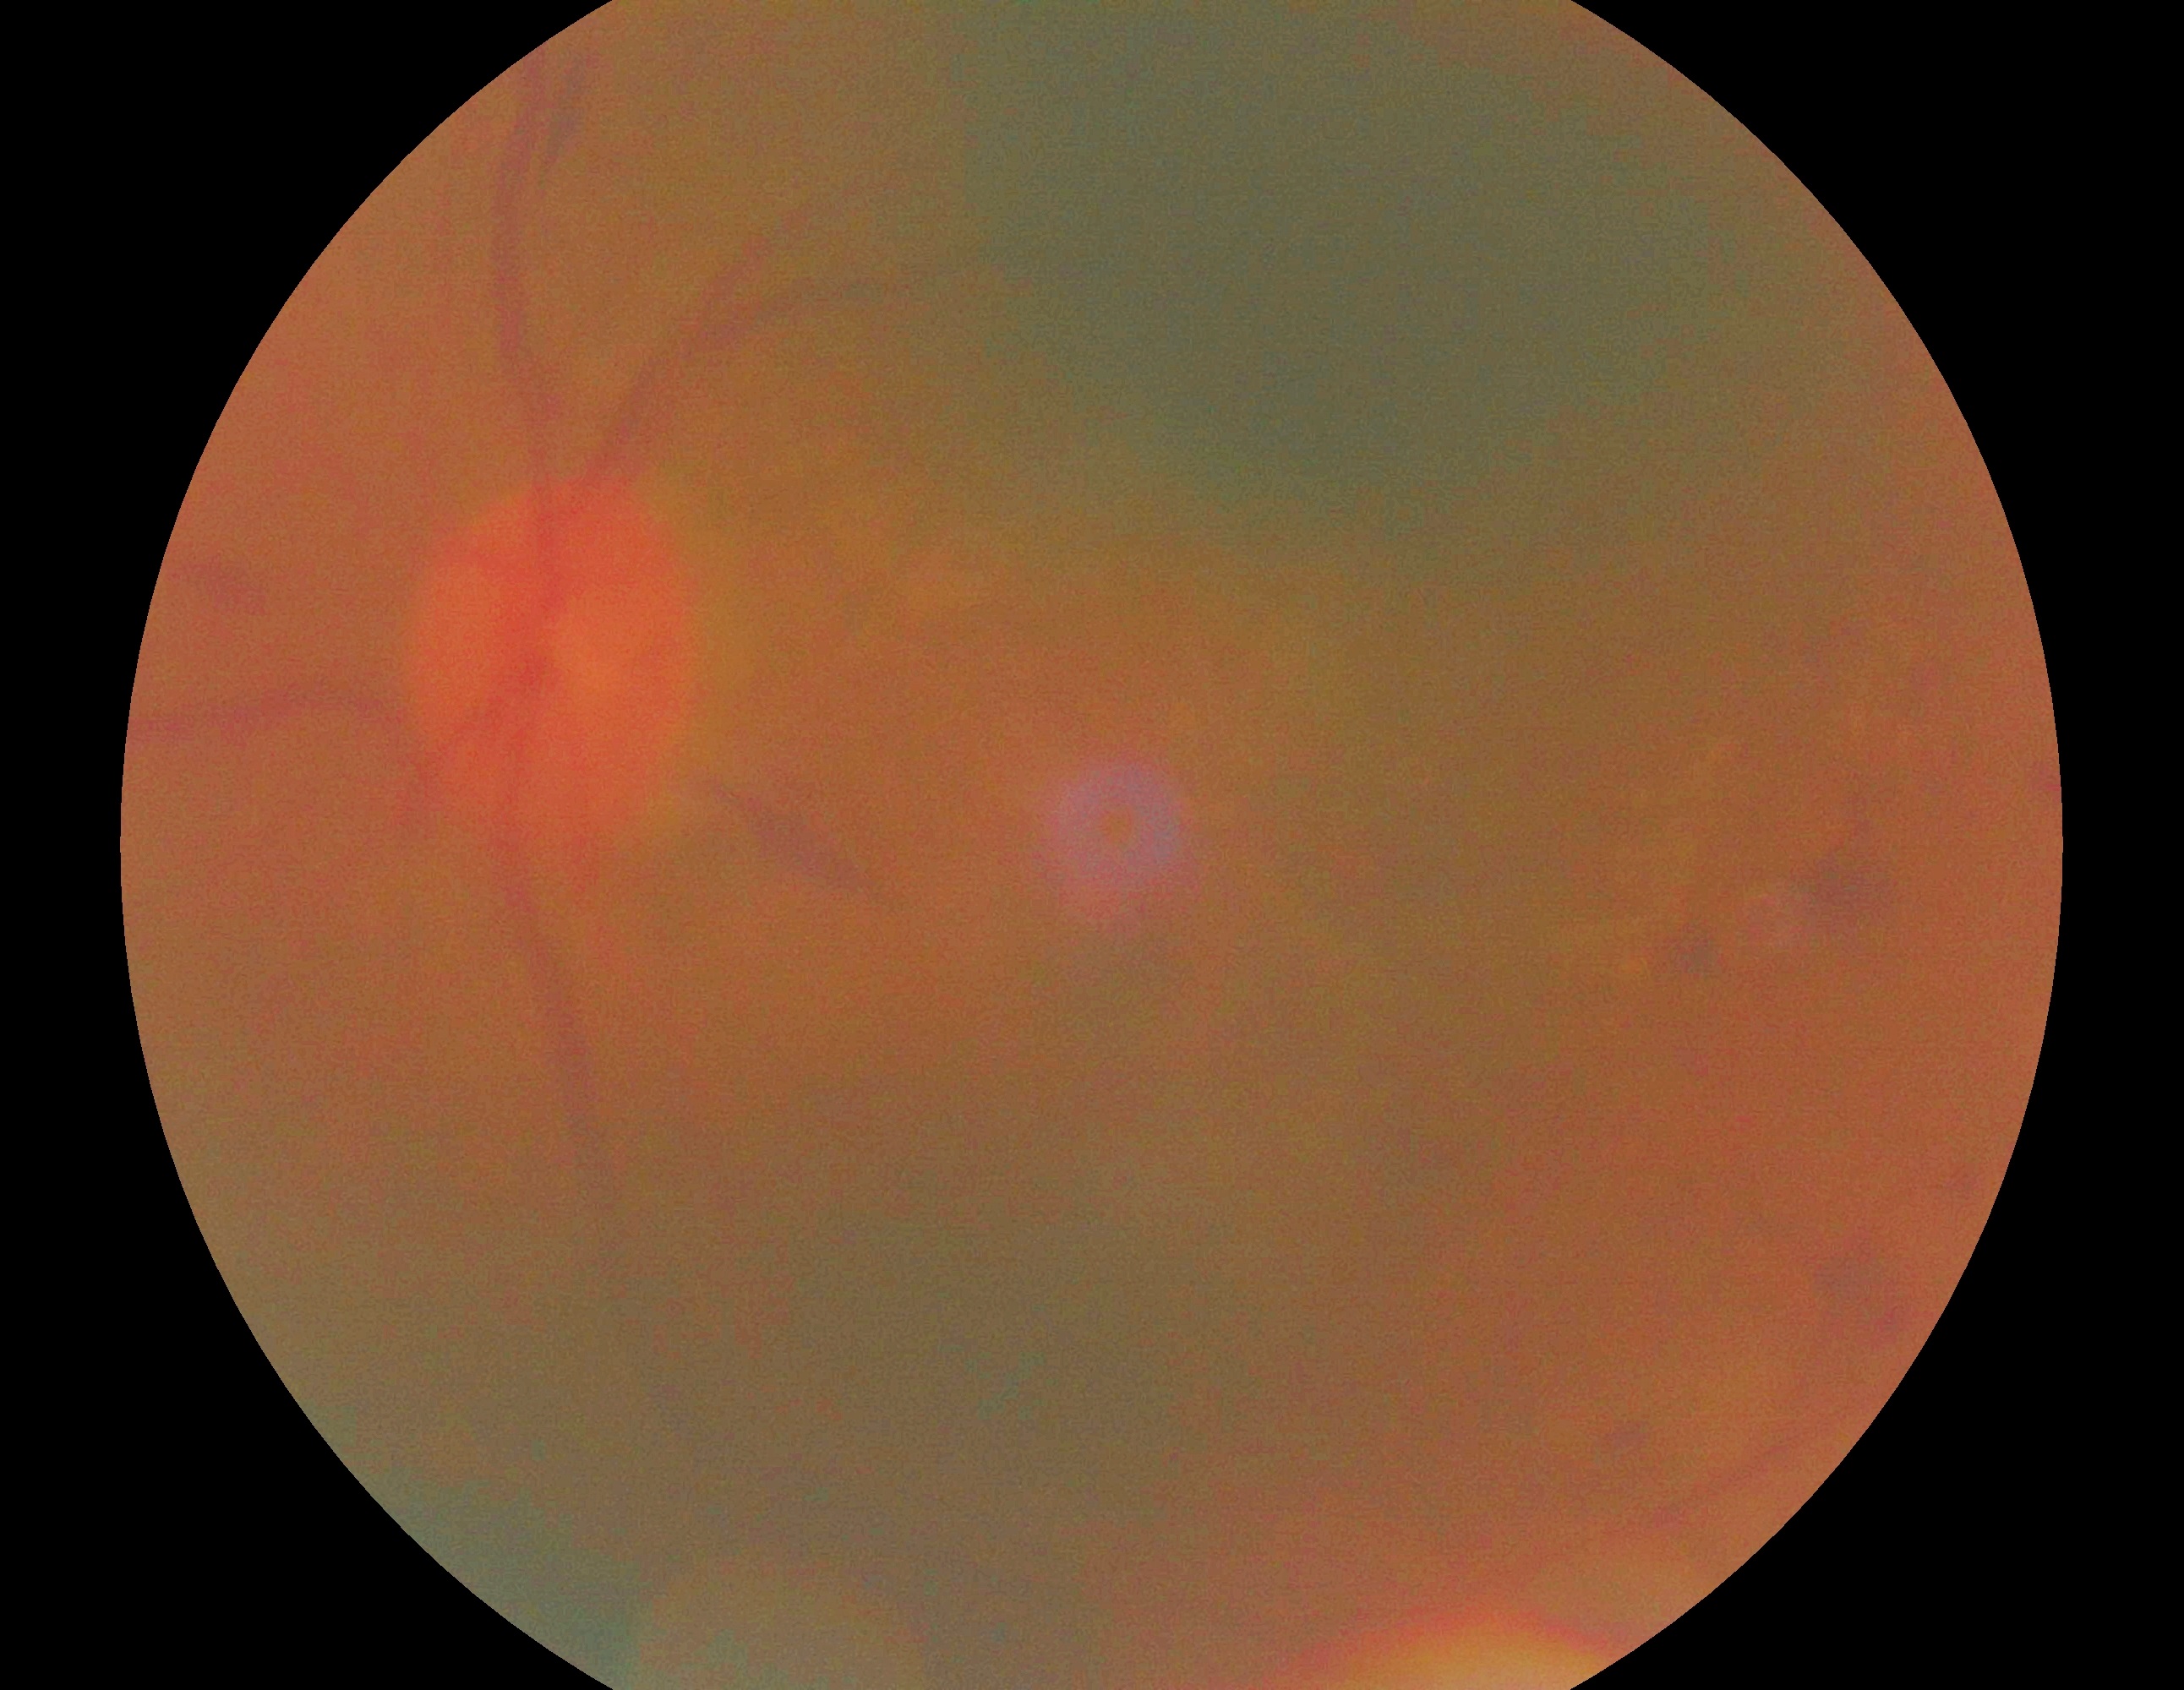 {"dr_grade": "grade 2 (moderate NPDR)"}